CFP · 2048x1536px — 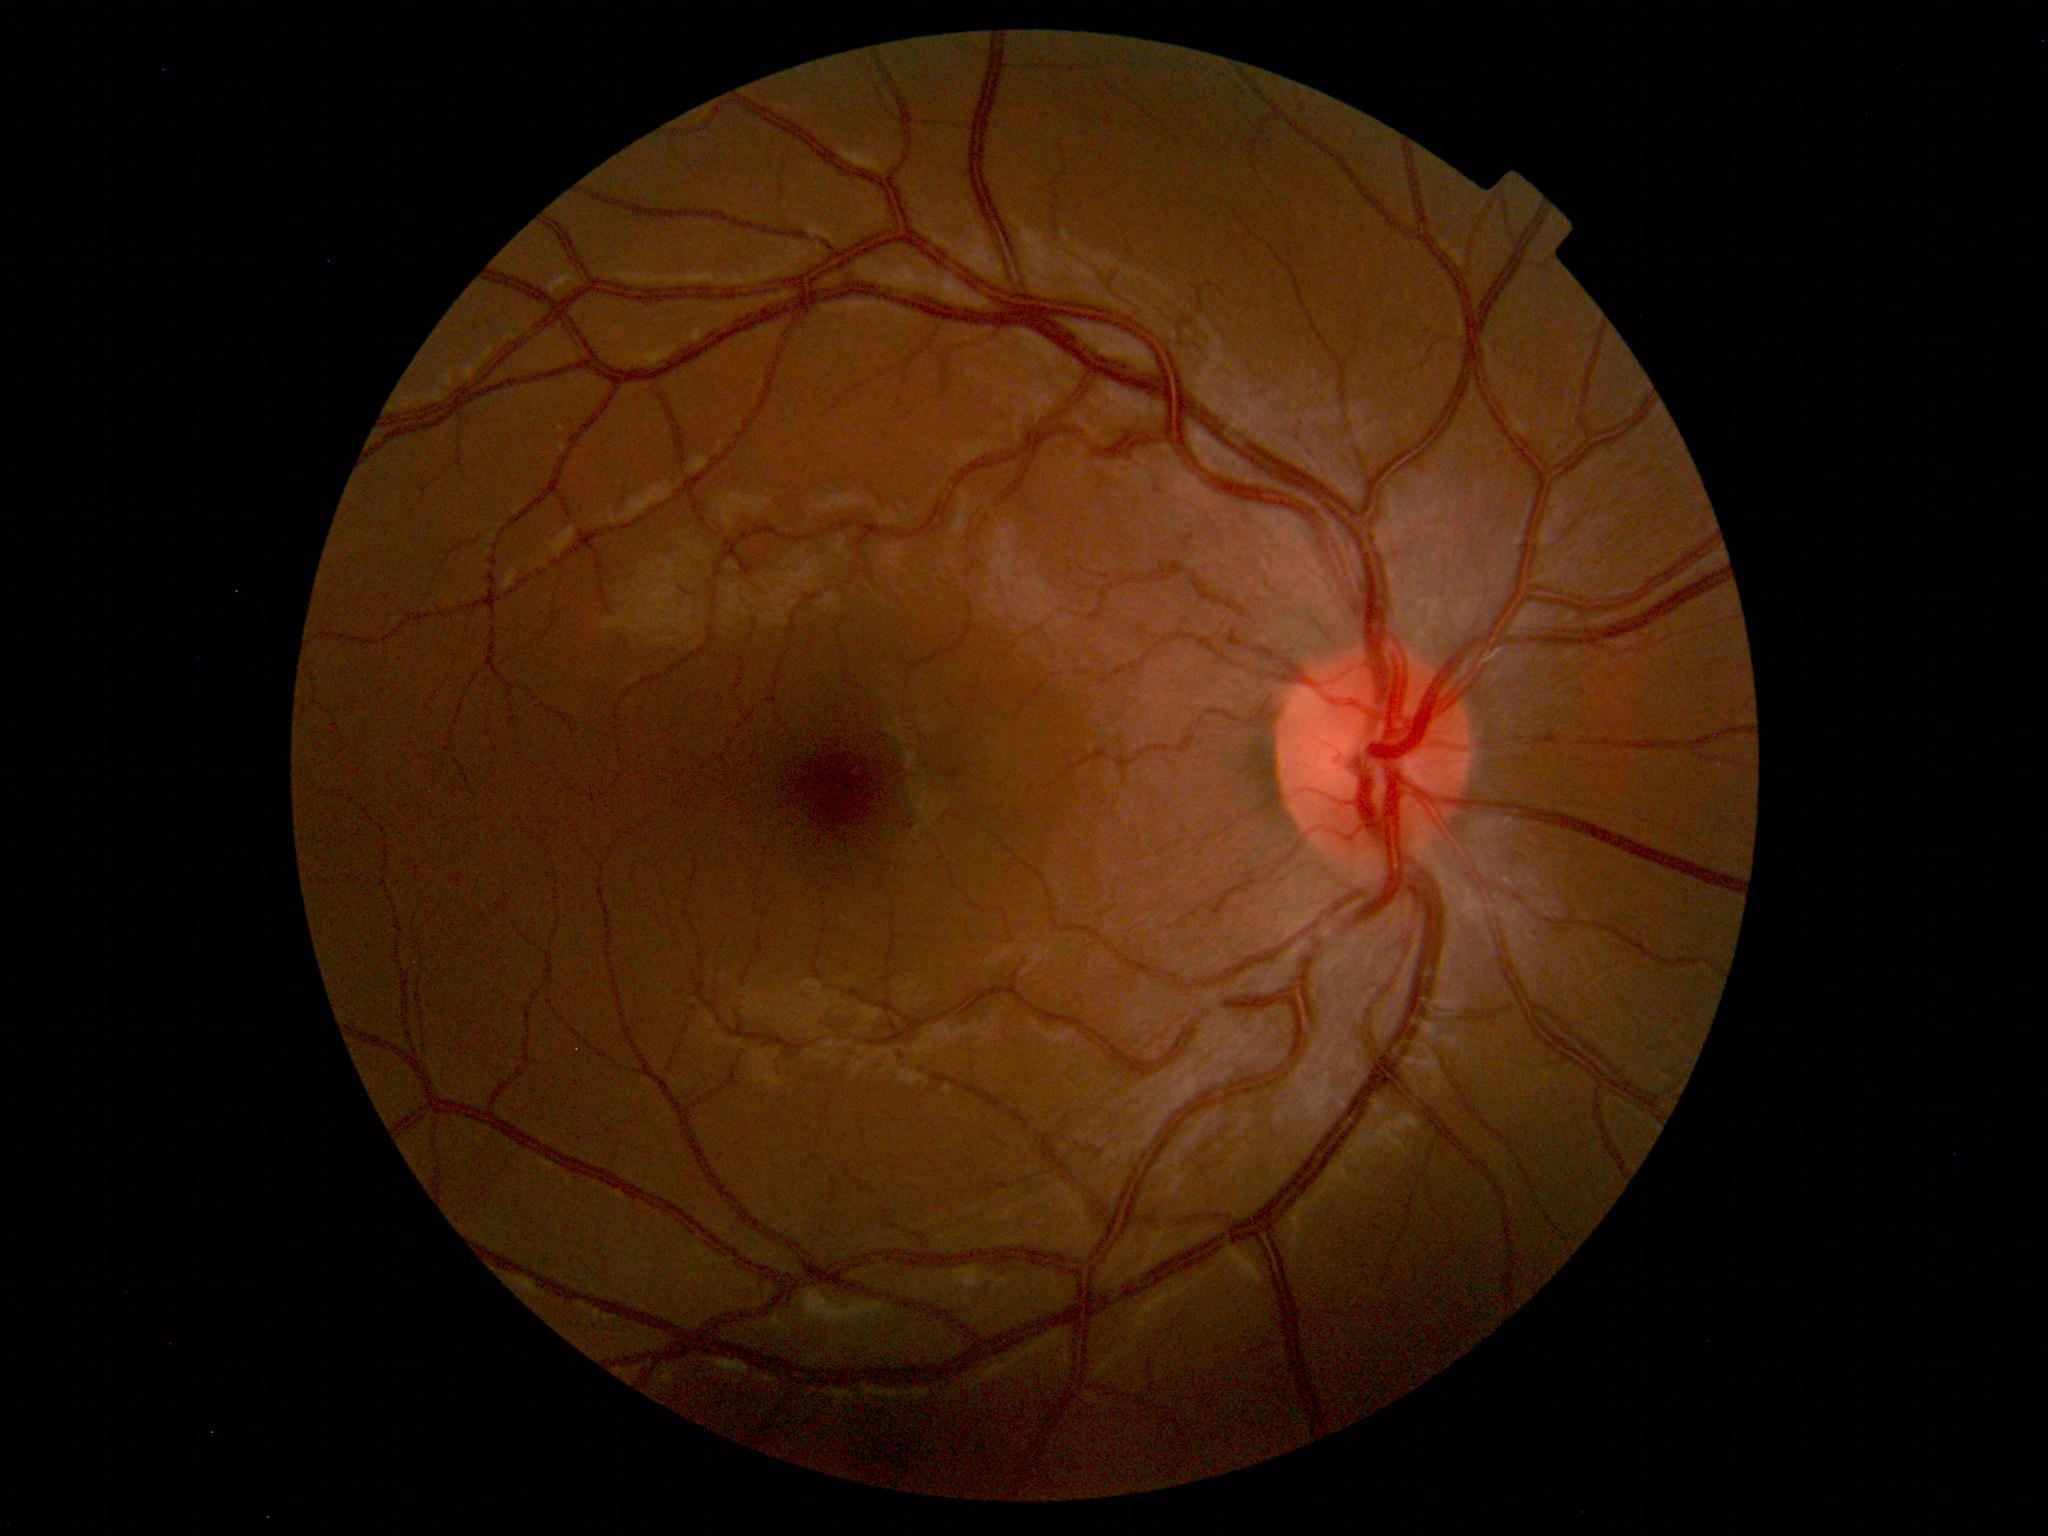

The fundus appears normal with no pathological findings.